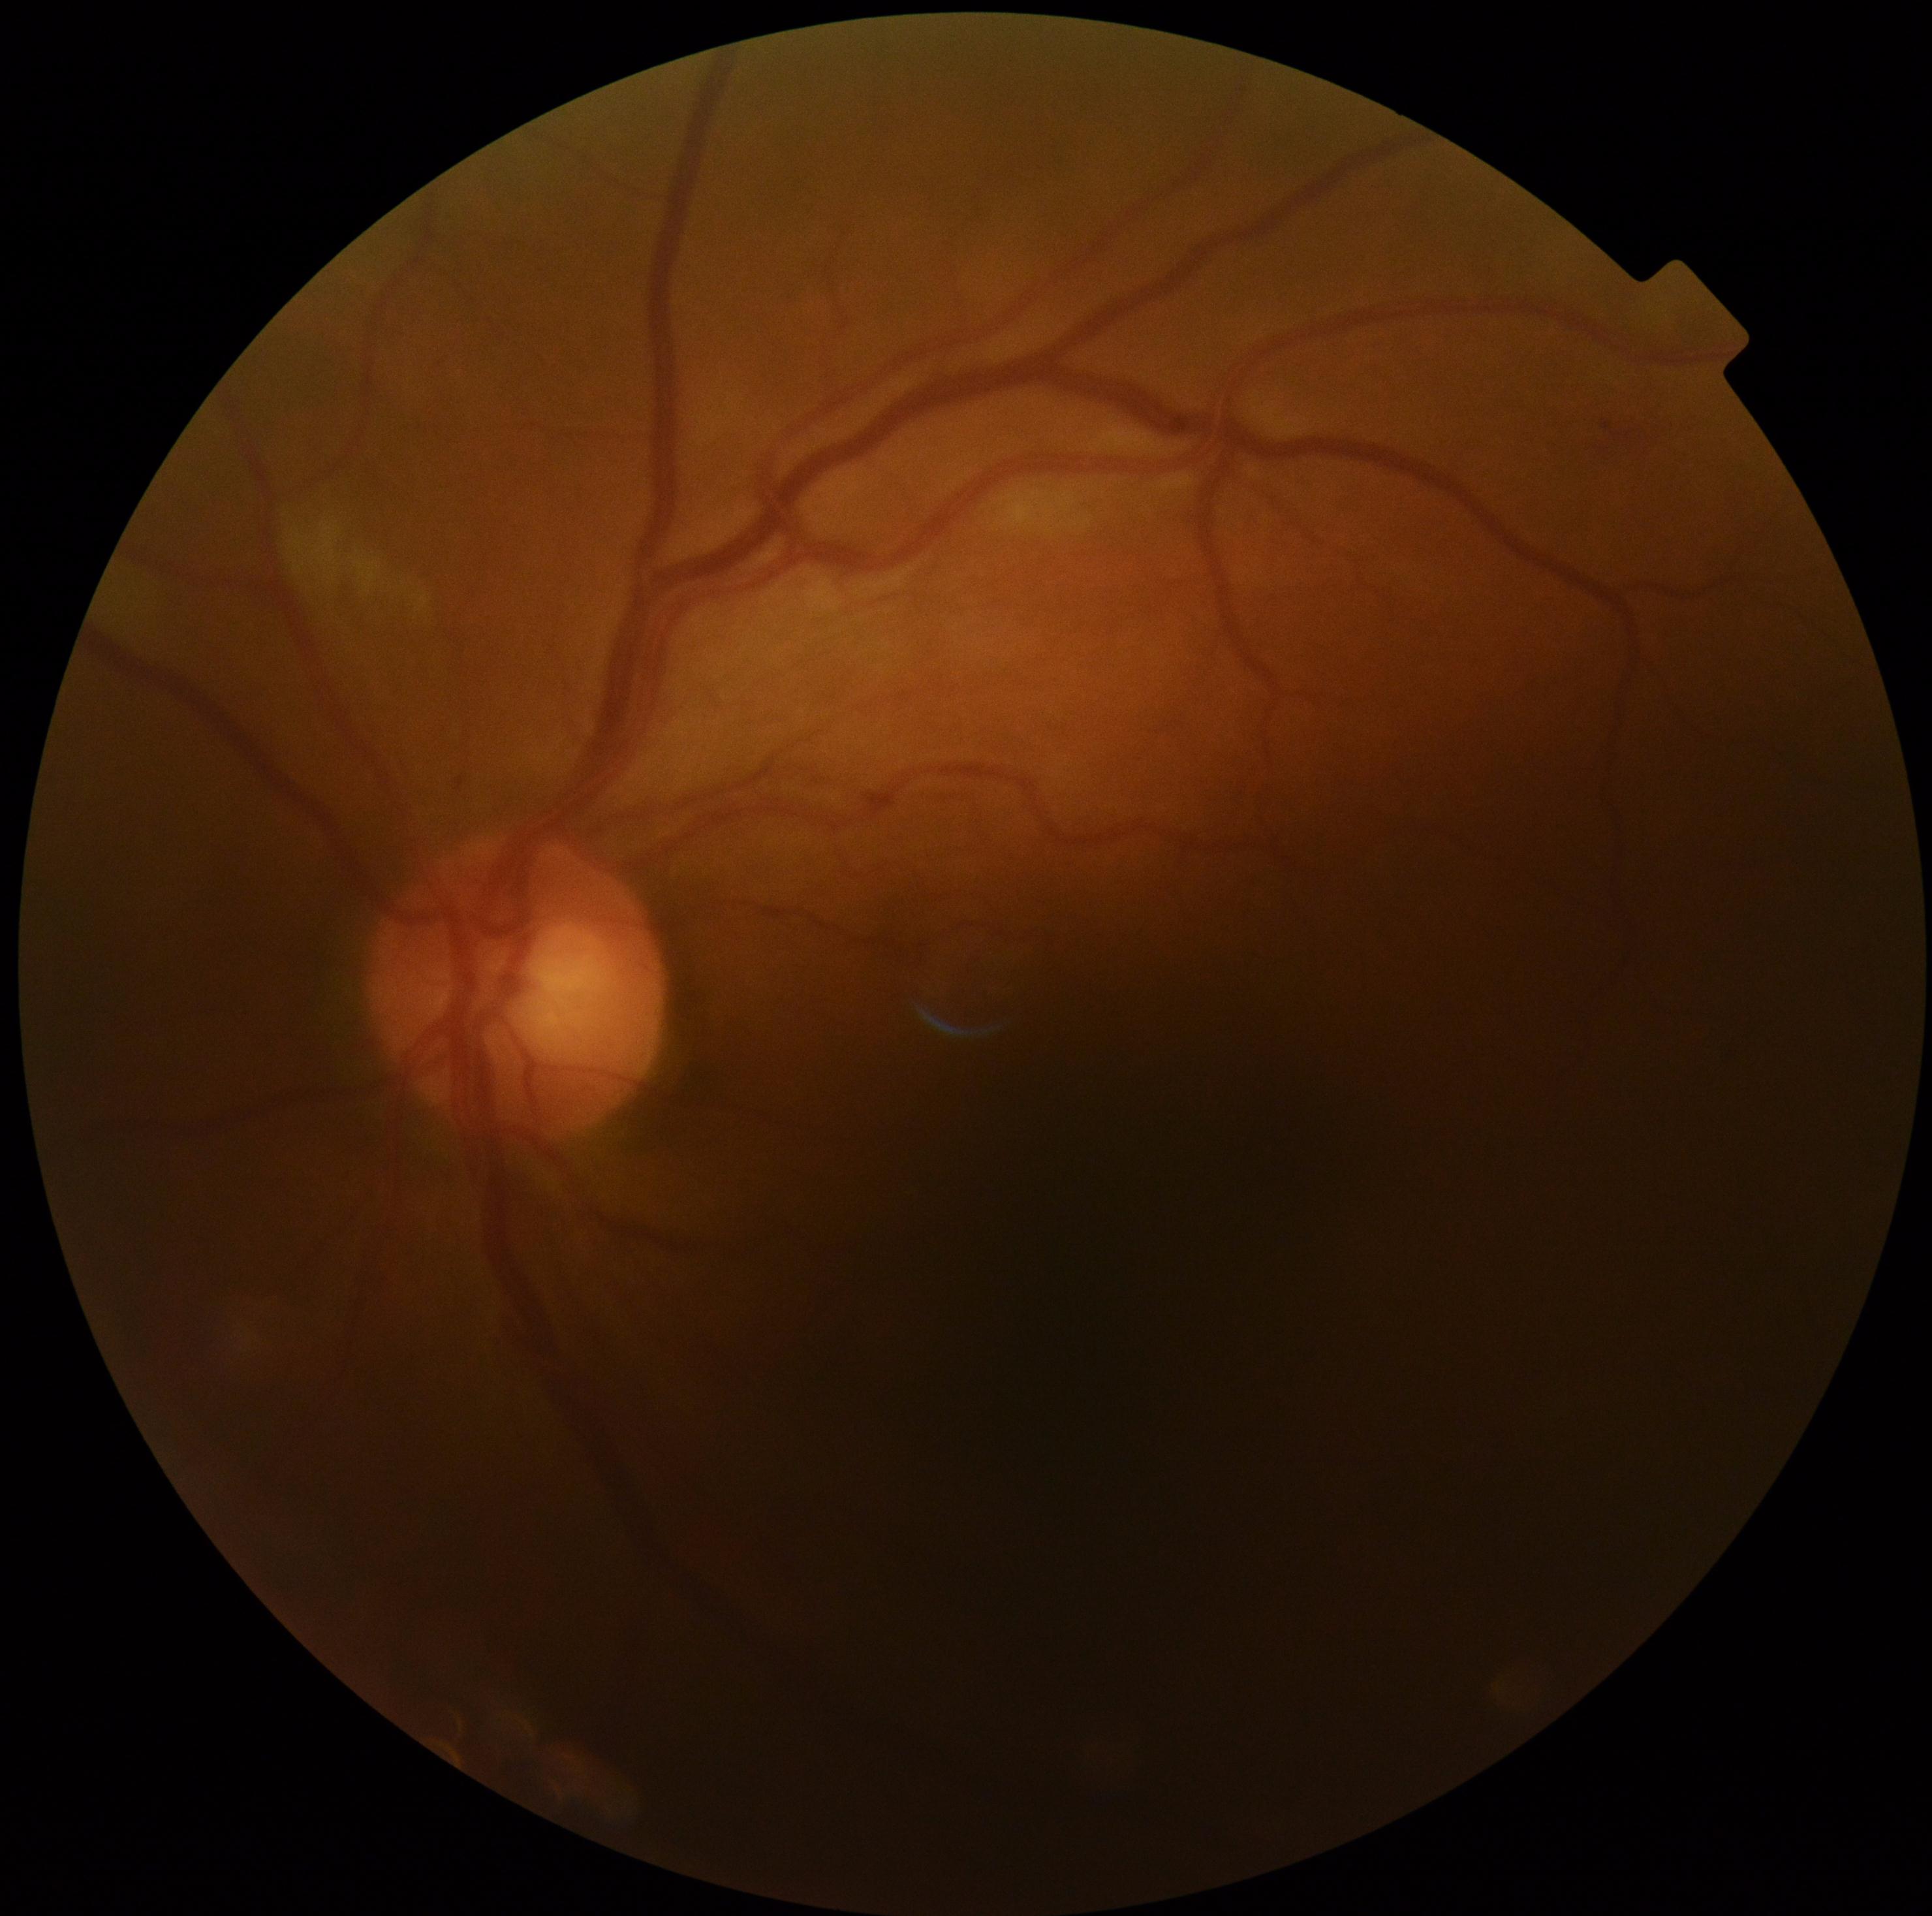
Retinopathy: 2.